2228x1652px:
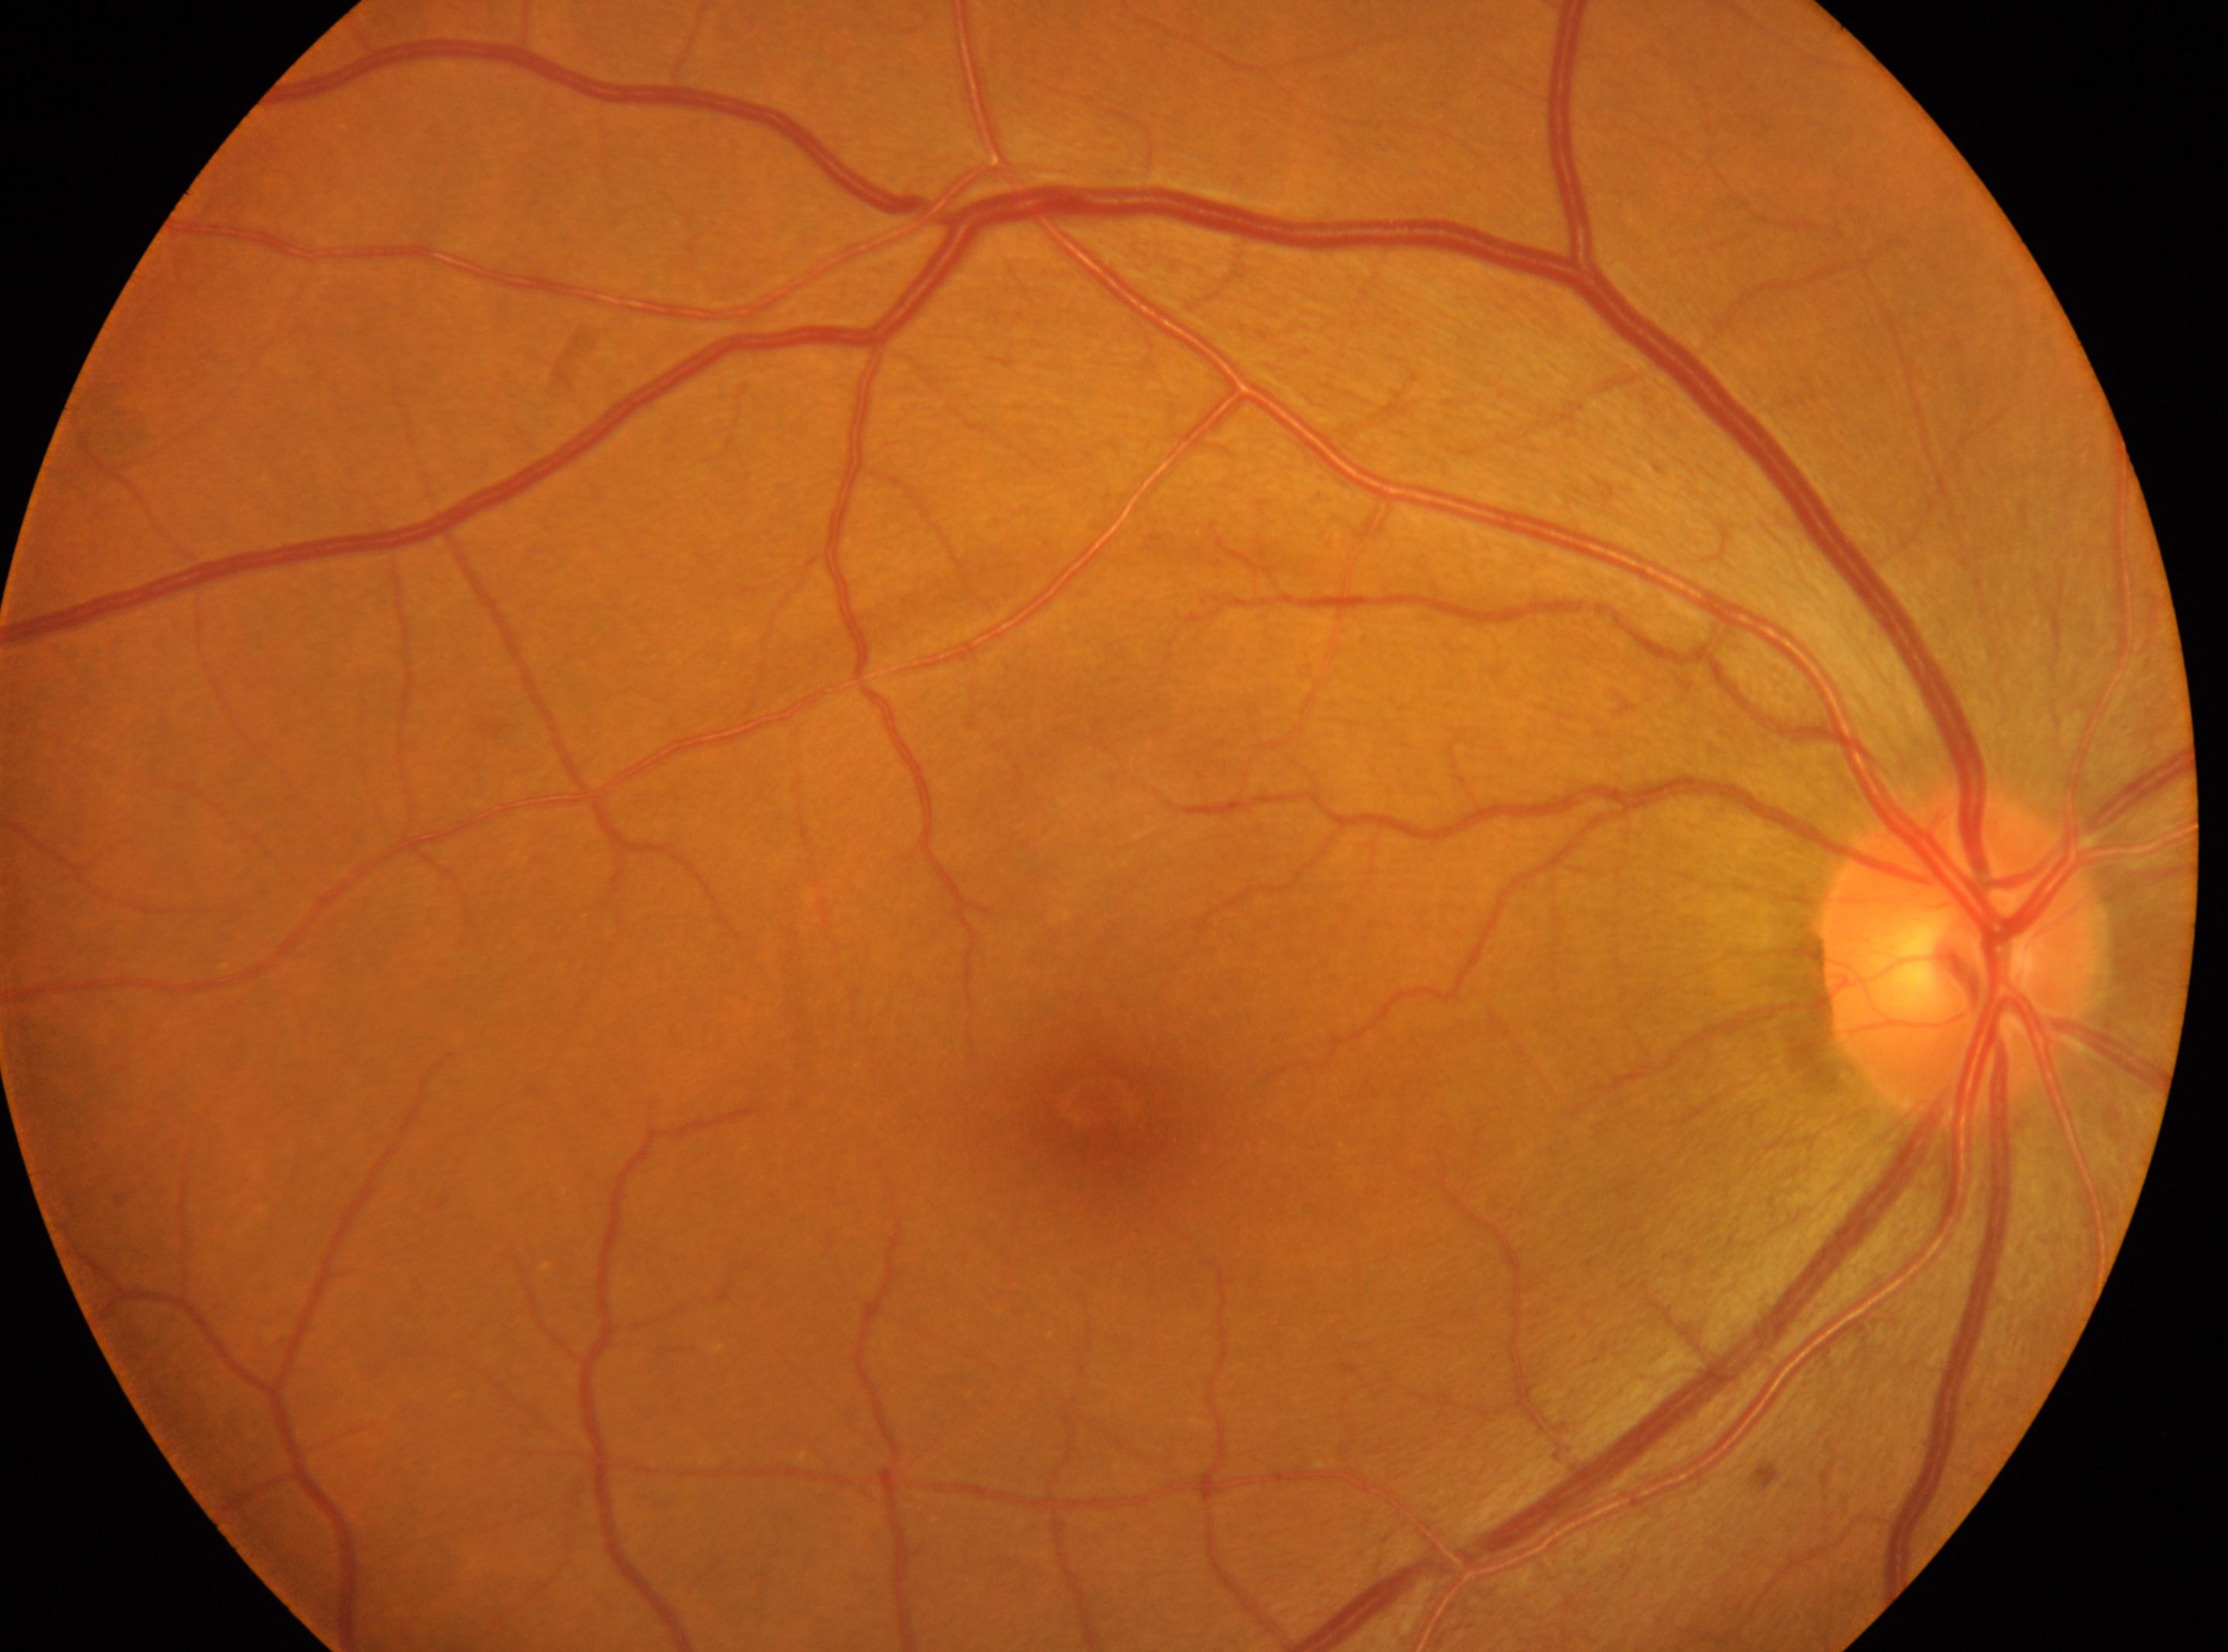

The image shows the OD. The optic disk is at (1958, 958). DR is 0/4. Foveal center located at (1100, 1104). No signs of diabetic retinopathy.